Captured with the Clarity RetCam 3 (130° field of view). Wide-field fundus photograph of an infant.
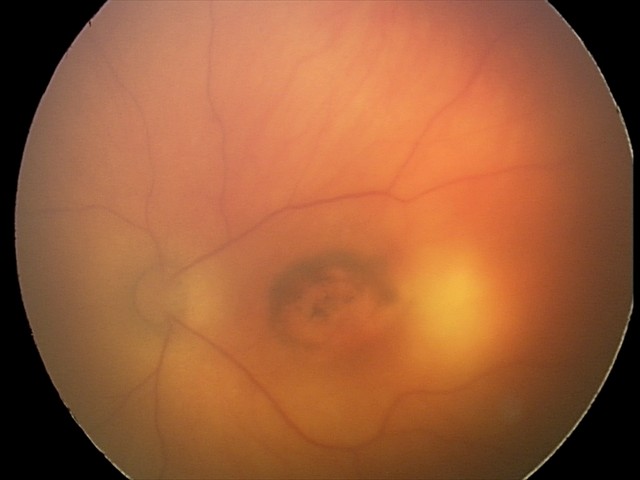 Screening series with toxoplasmosis chorioretinitis.